Color fundus photograph, 2048 x 1536 pixels — 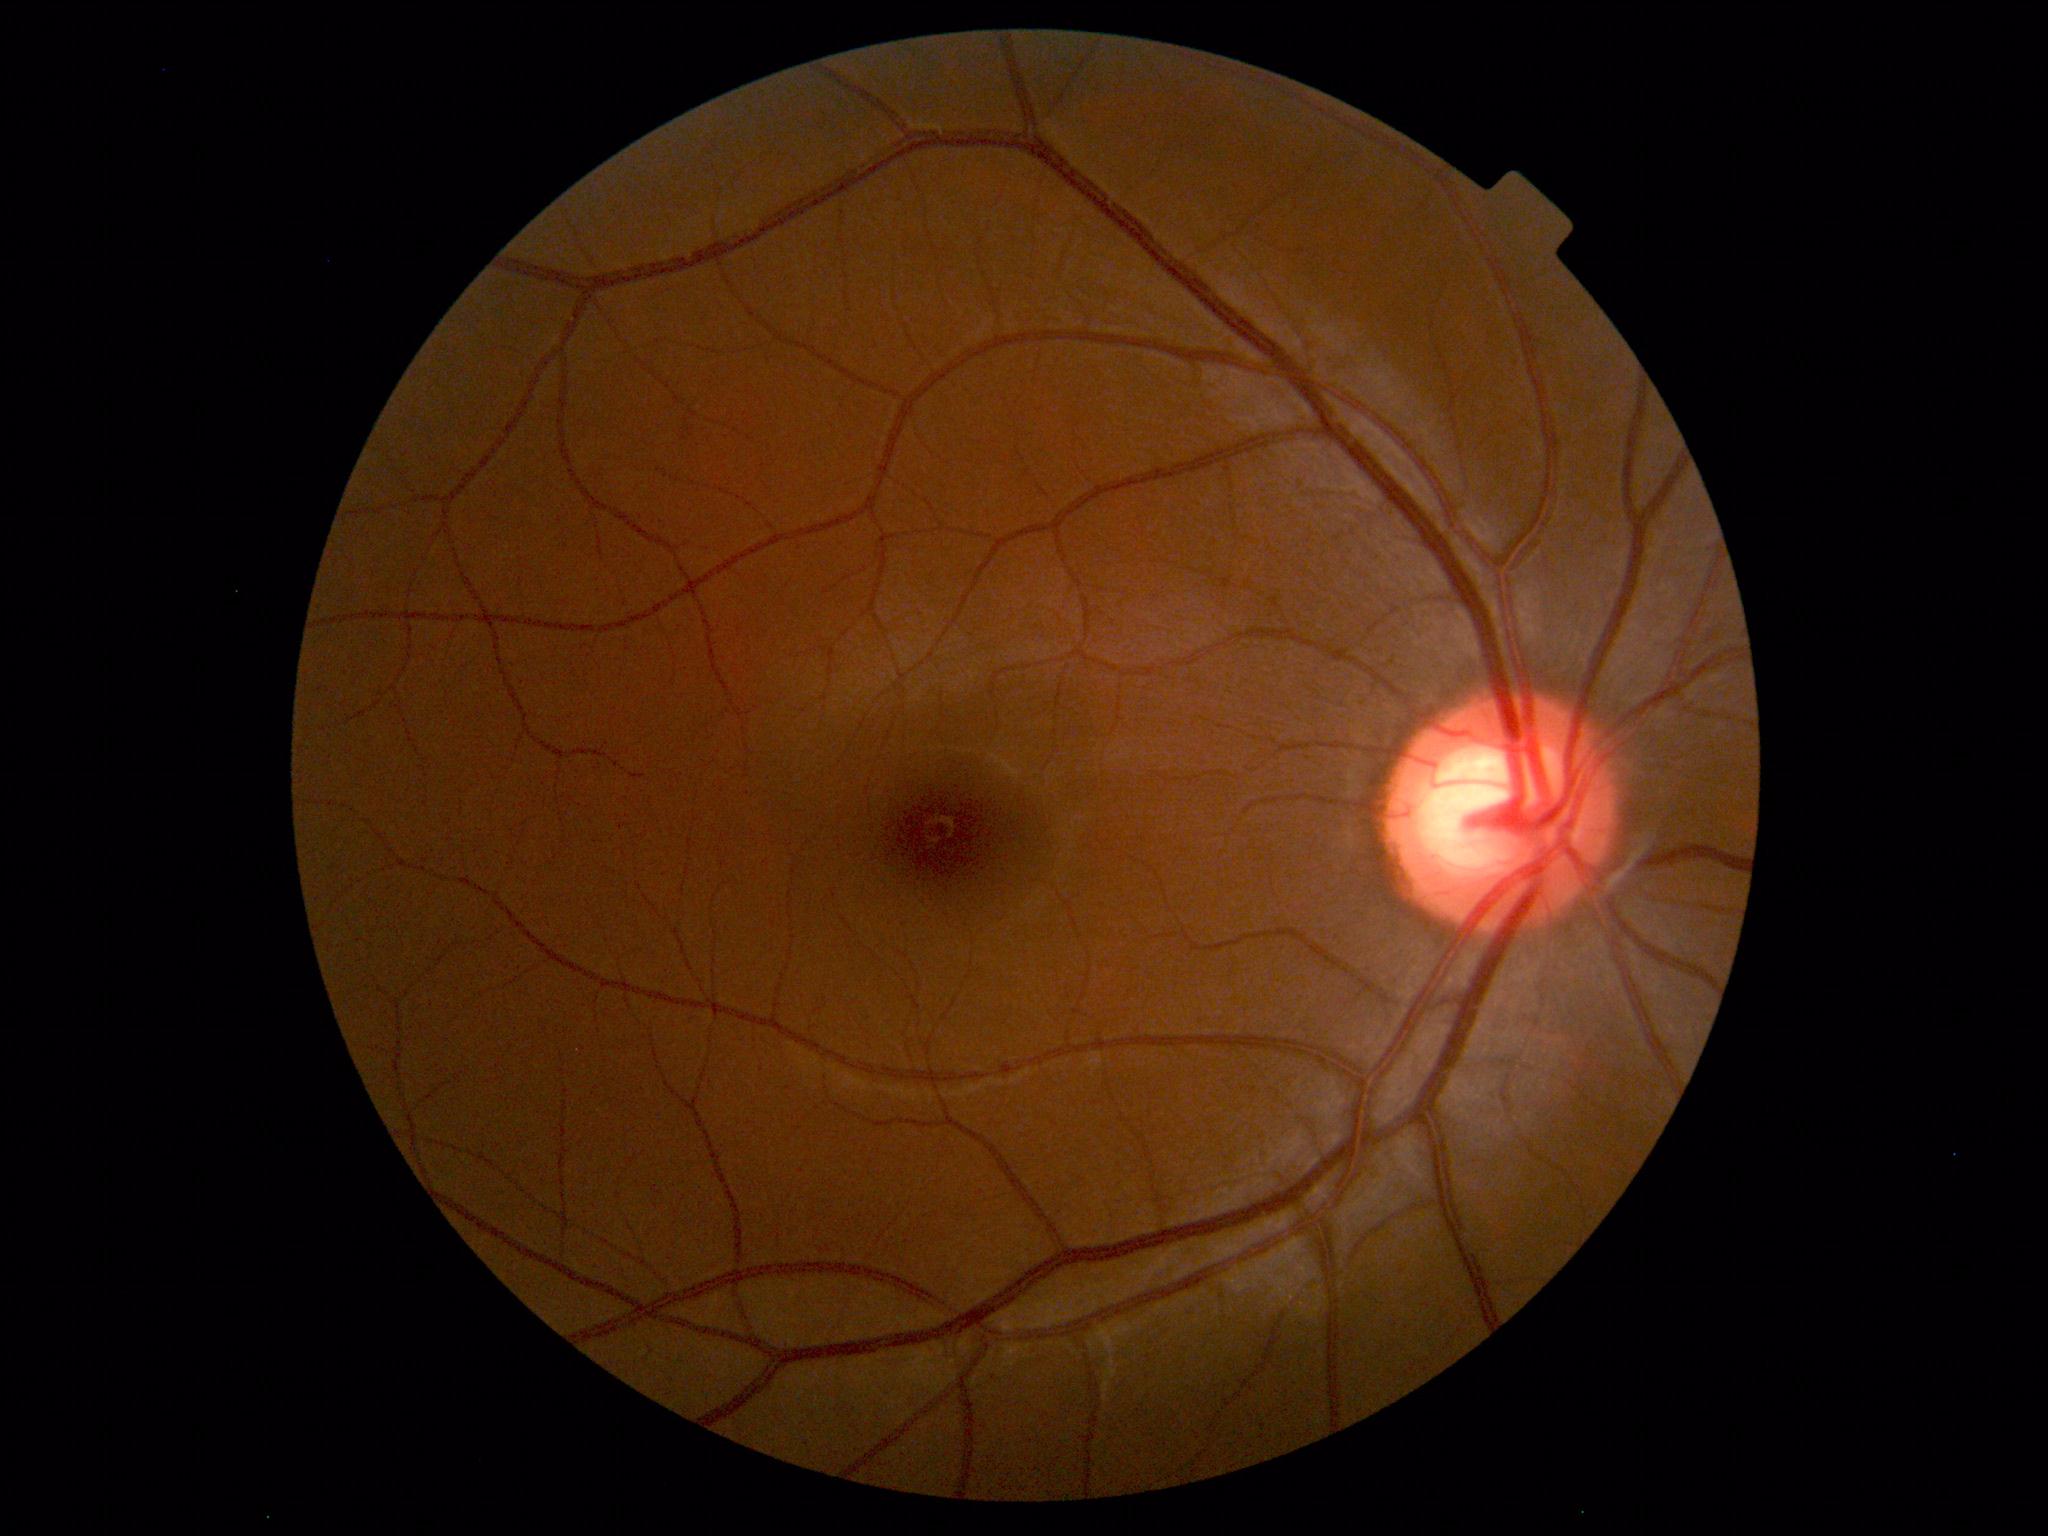
Diagnosis: normal.